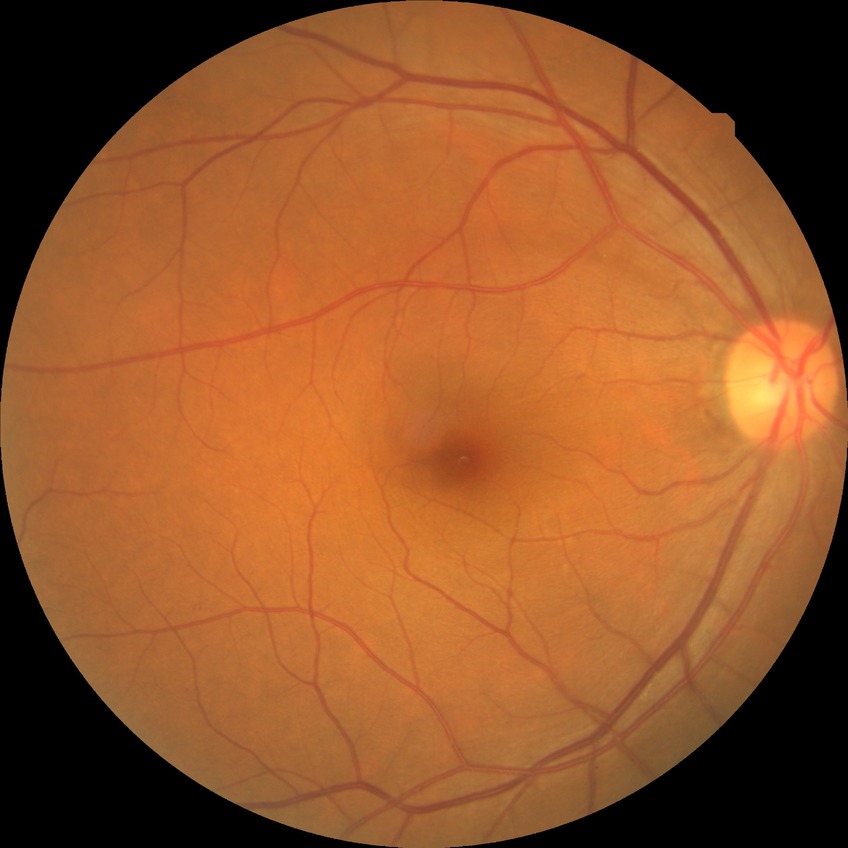 DR class: non-proliferative diabetic retinopathy. Diabetic retinopathy (DR) is SDR (simple diabetic retinopathy).